2352 by 1568 pixels; color fundus image: 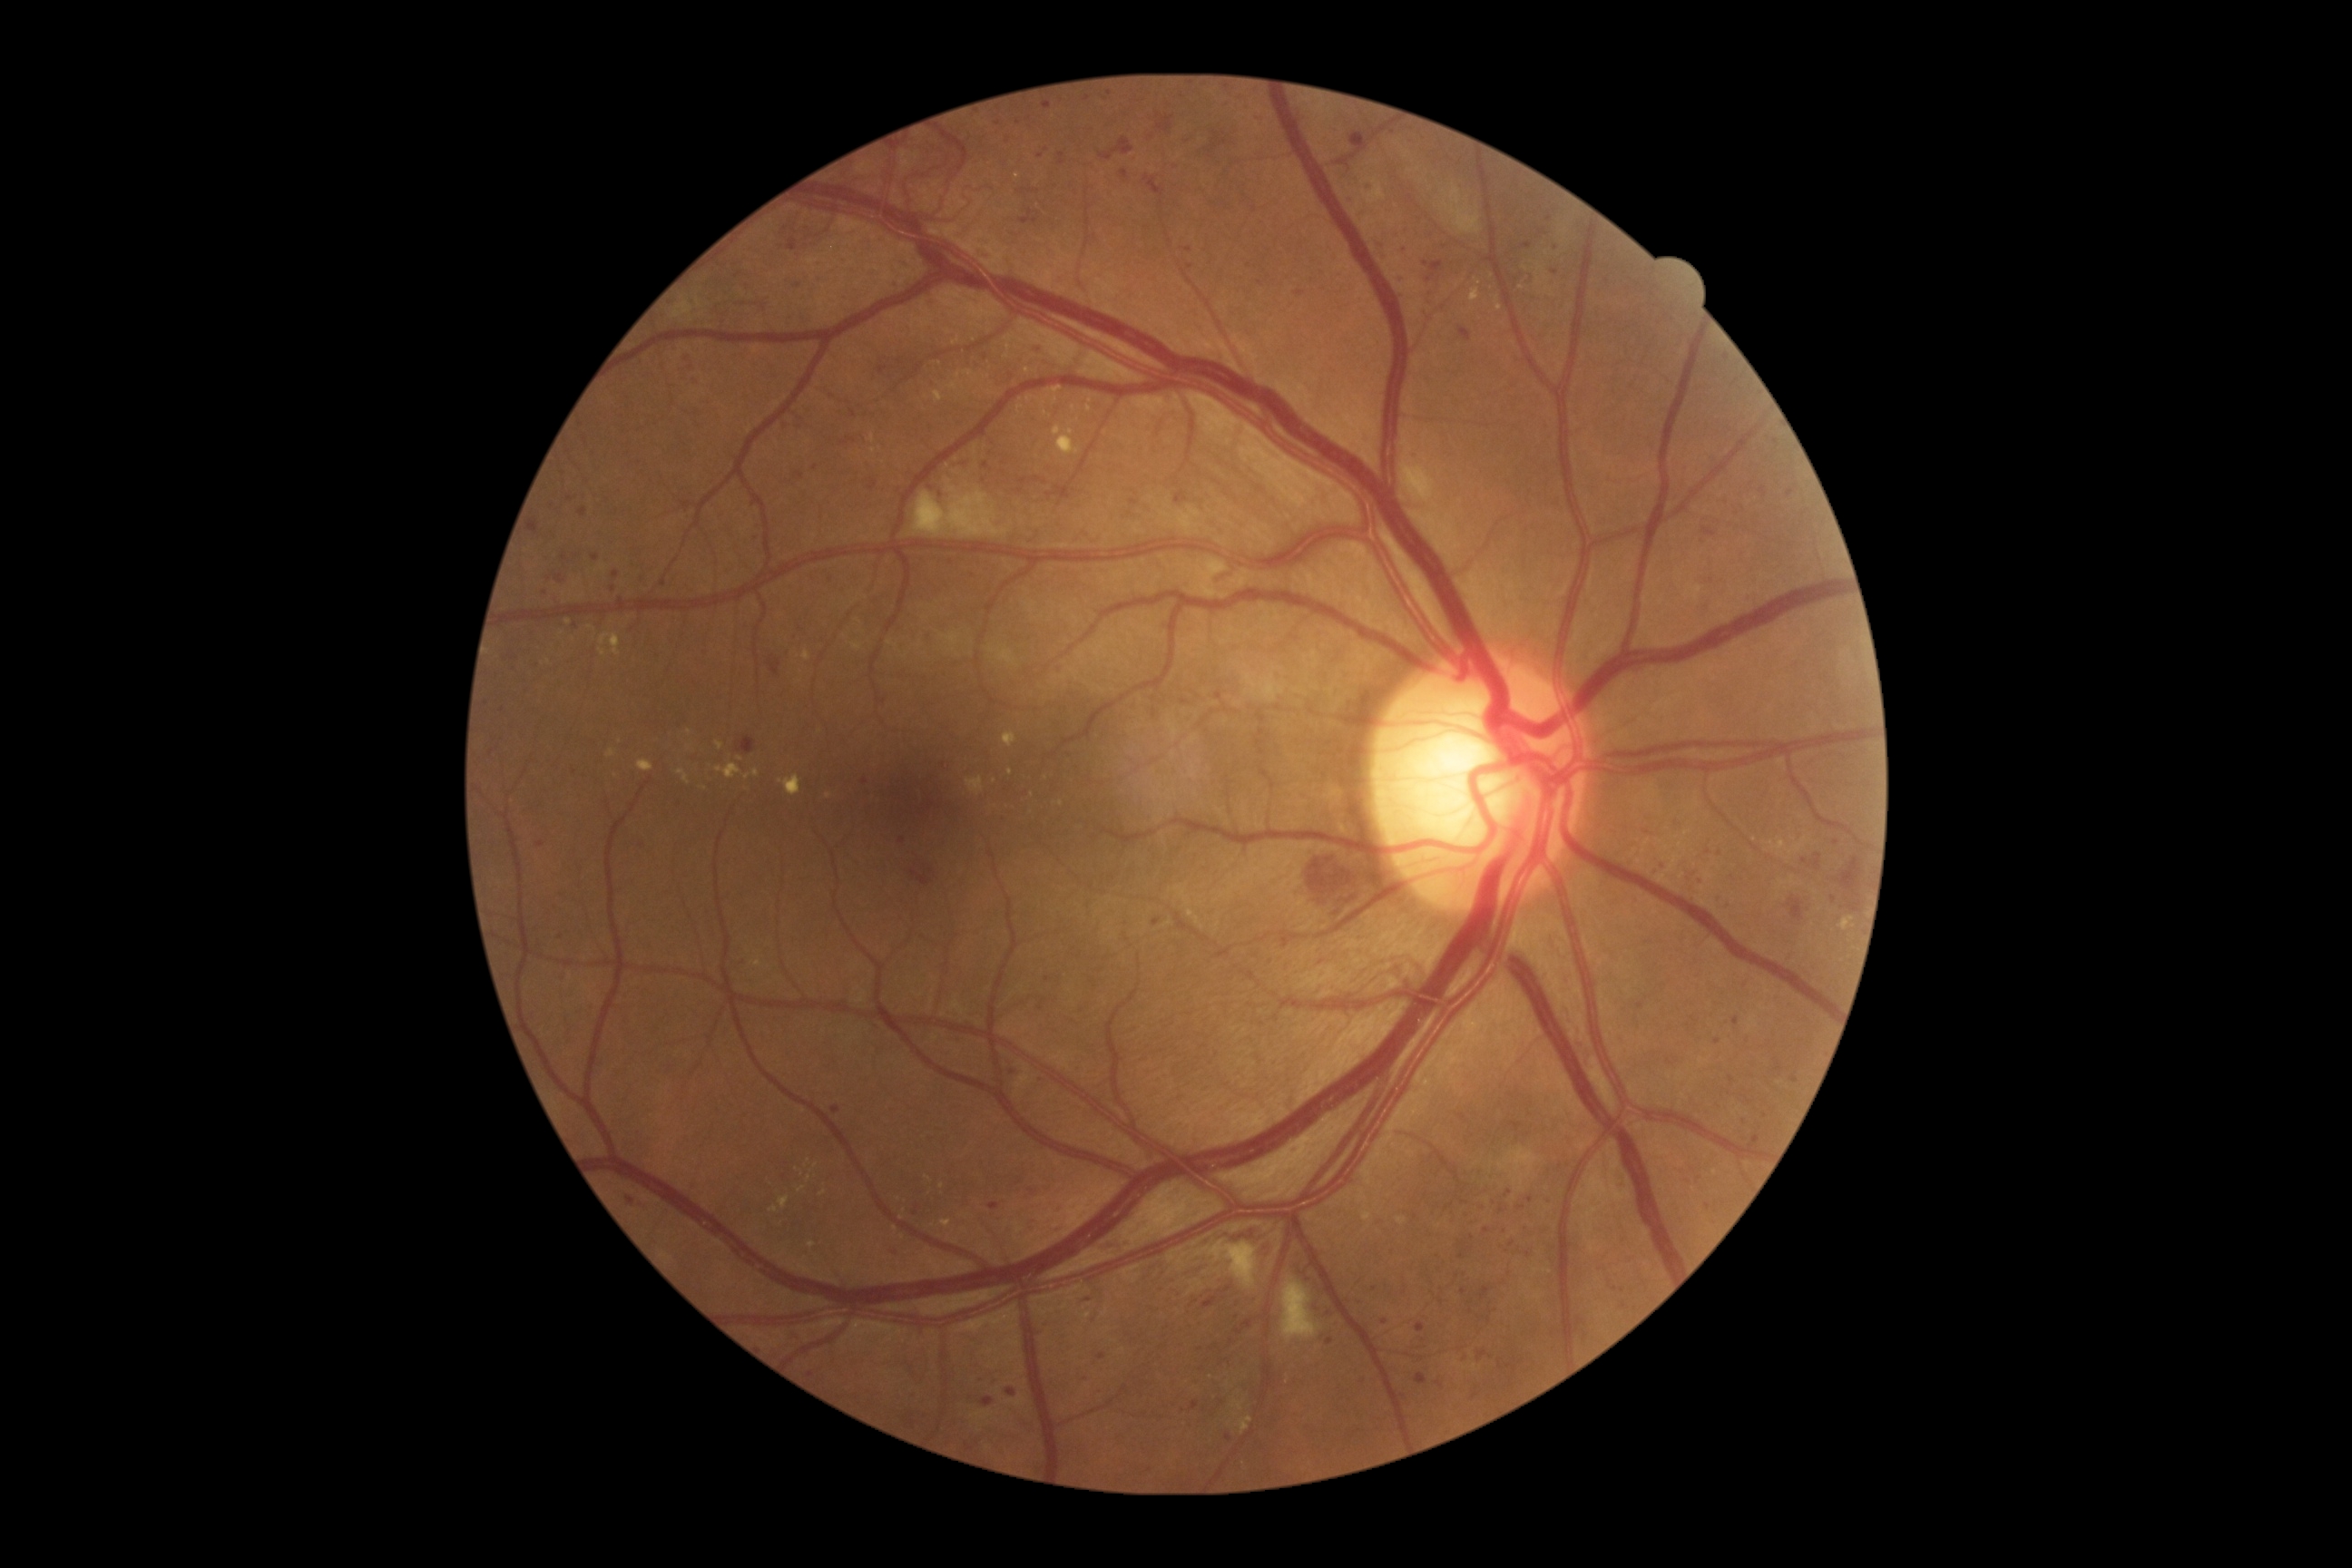

<lesions partial="true">
  <dr_grade>3</dr_grade>
  <ma partial="true">box(1378, 255, 1387, 262); box(903, 259, 912, 268); box(1398, 277, 1406, 282); box(1280, 939, 1289, 950); box(1400, 248, 1406, 257); box(593, 554, 600, 562); box(981, 1398, 995, 1407); box(787, 239, 798, 251); box(618, 598, 625, 607)</ma>
  <ma_small>x=931 y=1138; x=1530 y=1200; x=738 y=276; x=899 y=284; x=1555 y=273; x=1239 y=1332; x=816 y=468; x=1019 y=122; x=1640 y=1007; x=1623 y=1291</ma_small>
</lesions>